Modified Davis grading. NIDEK AFC-230. 45° field of view — 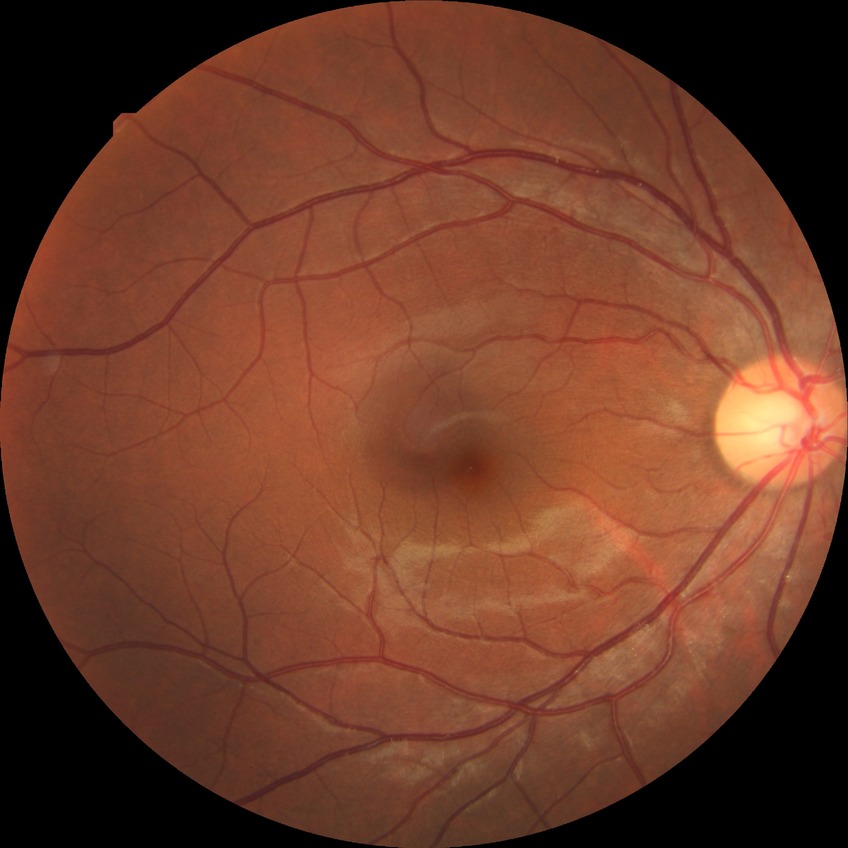

Diabetic retinopathy (DR) is no diabetic retinopathy (NDR).